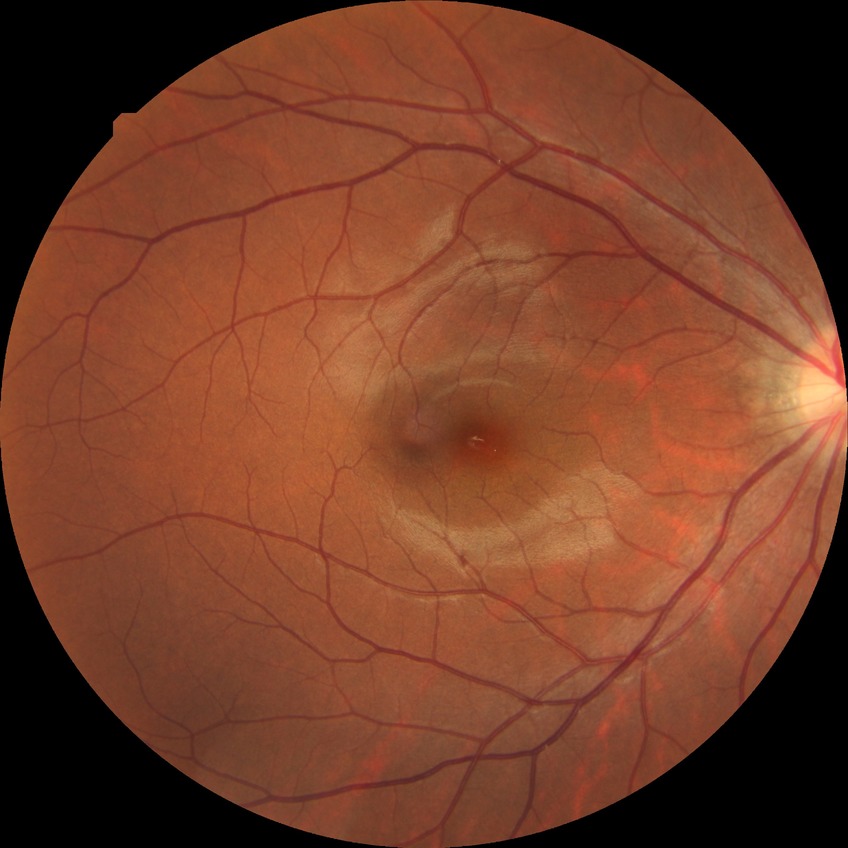
Davis grading: no diabetic retinopathy.